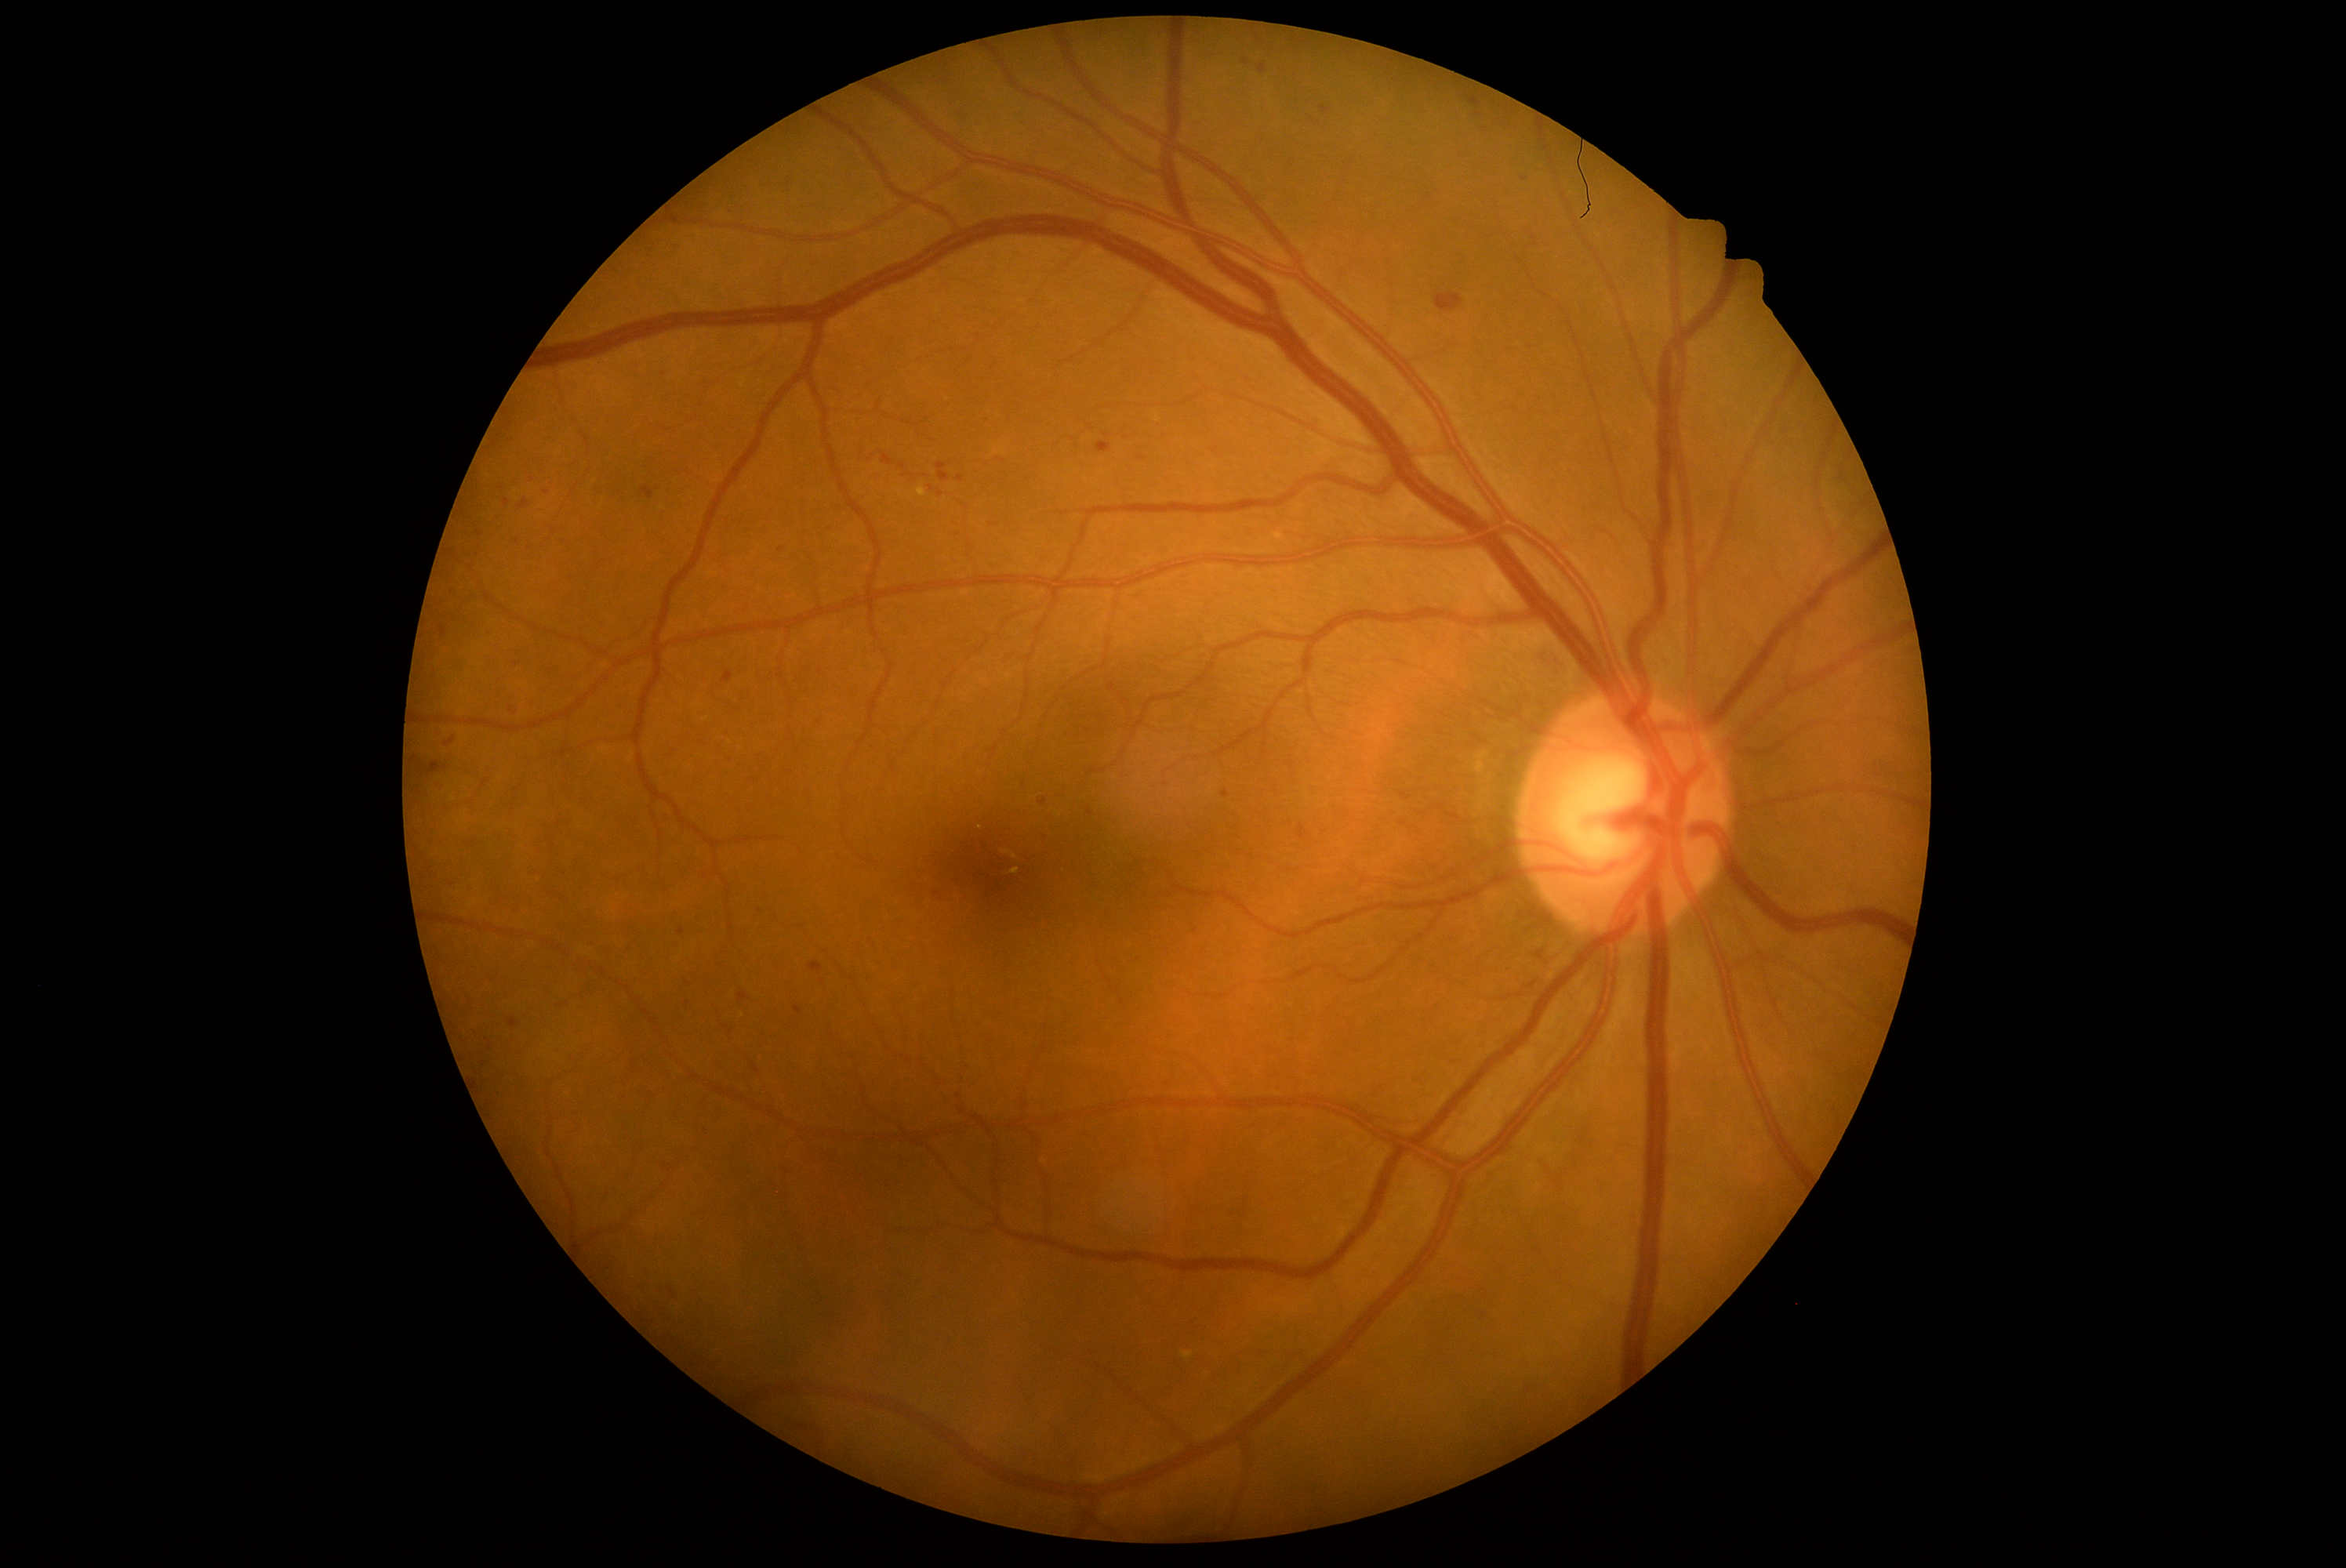
partial: true
dr_grade: 2
dr_grade_name: moderate NPDR
lesions:
  he:
    - left=440, top=625, right=448, bottom=637
    - left=510, top=477, right=521, bottom=487
    - left=1097, top=443, right=1111, bottom=454
    - left=600, top=945, right=614, bottom=957
    - left=1456, top=150, right=1469, bottom=161
    - left=881, top=451, right=895, bottom=466
    - left=957, top=476, right=965, bottom=482
    - left=583, top=940, right=594, bottom=946
    - left=559, top=1003, right=568, bottom=1009
    - left=463, top=833, right=481, bottom=849
    - left=1470, top=98, right=1481, bottom=106
    - left=663, top=744, right=675, bottom=782
    - left=1059, top=512, right=1067, bottom=517
  he_small_approx:
    - 1486:1315
    - 818:722
    - 490:1047
    - 1525:180